NIDEK AFC-230 fundus camera · fundus photo · DR severity per modified Davis staging.
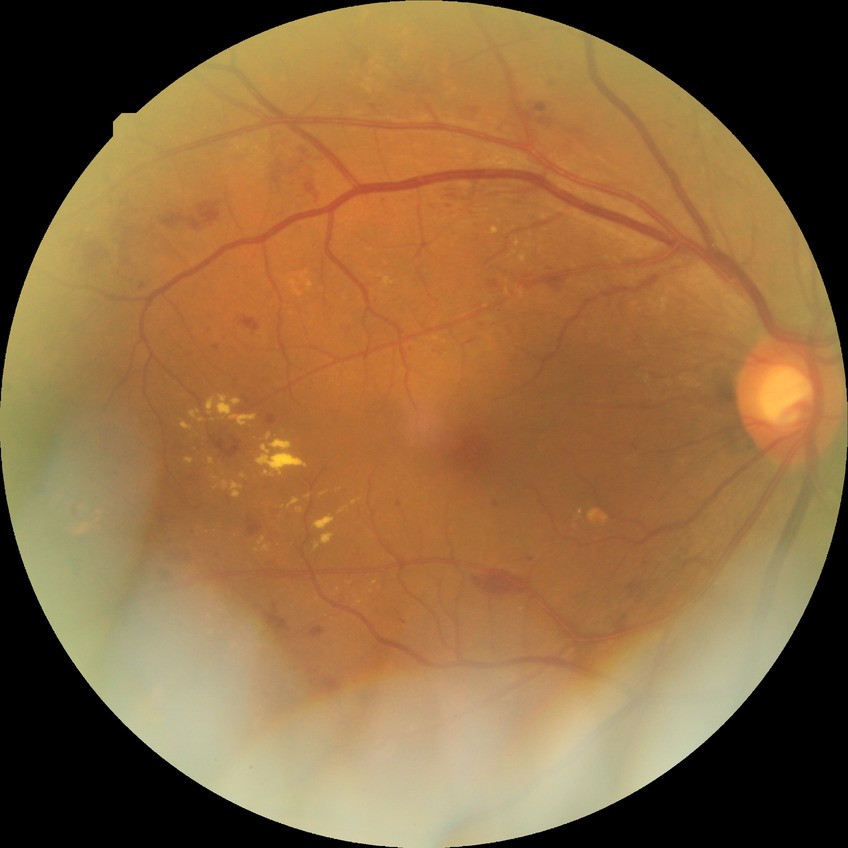

Diabetic retinopathy severity: pre-proliferative diabetic retinopathy.